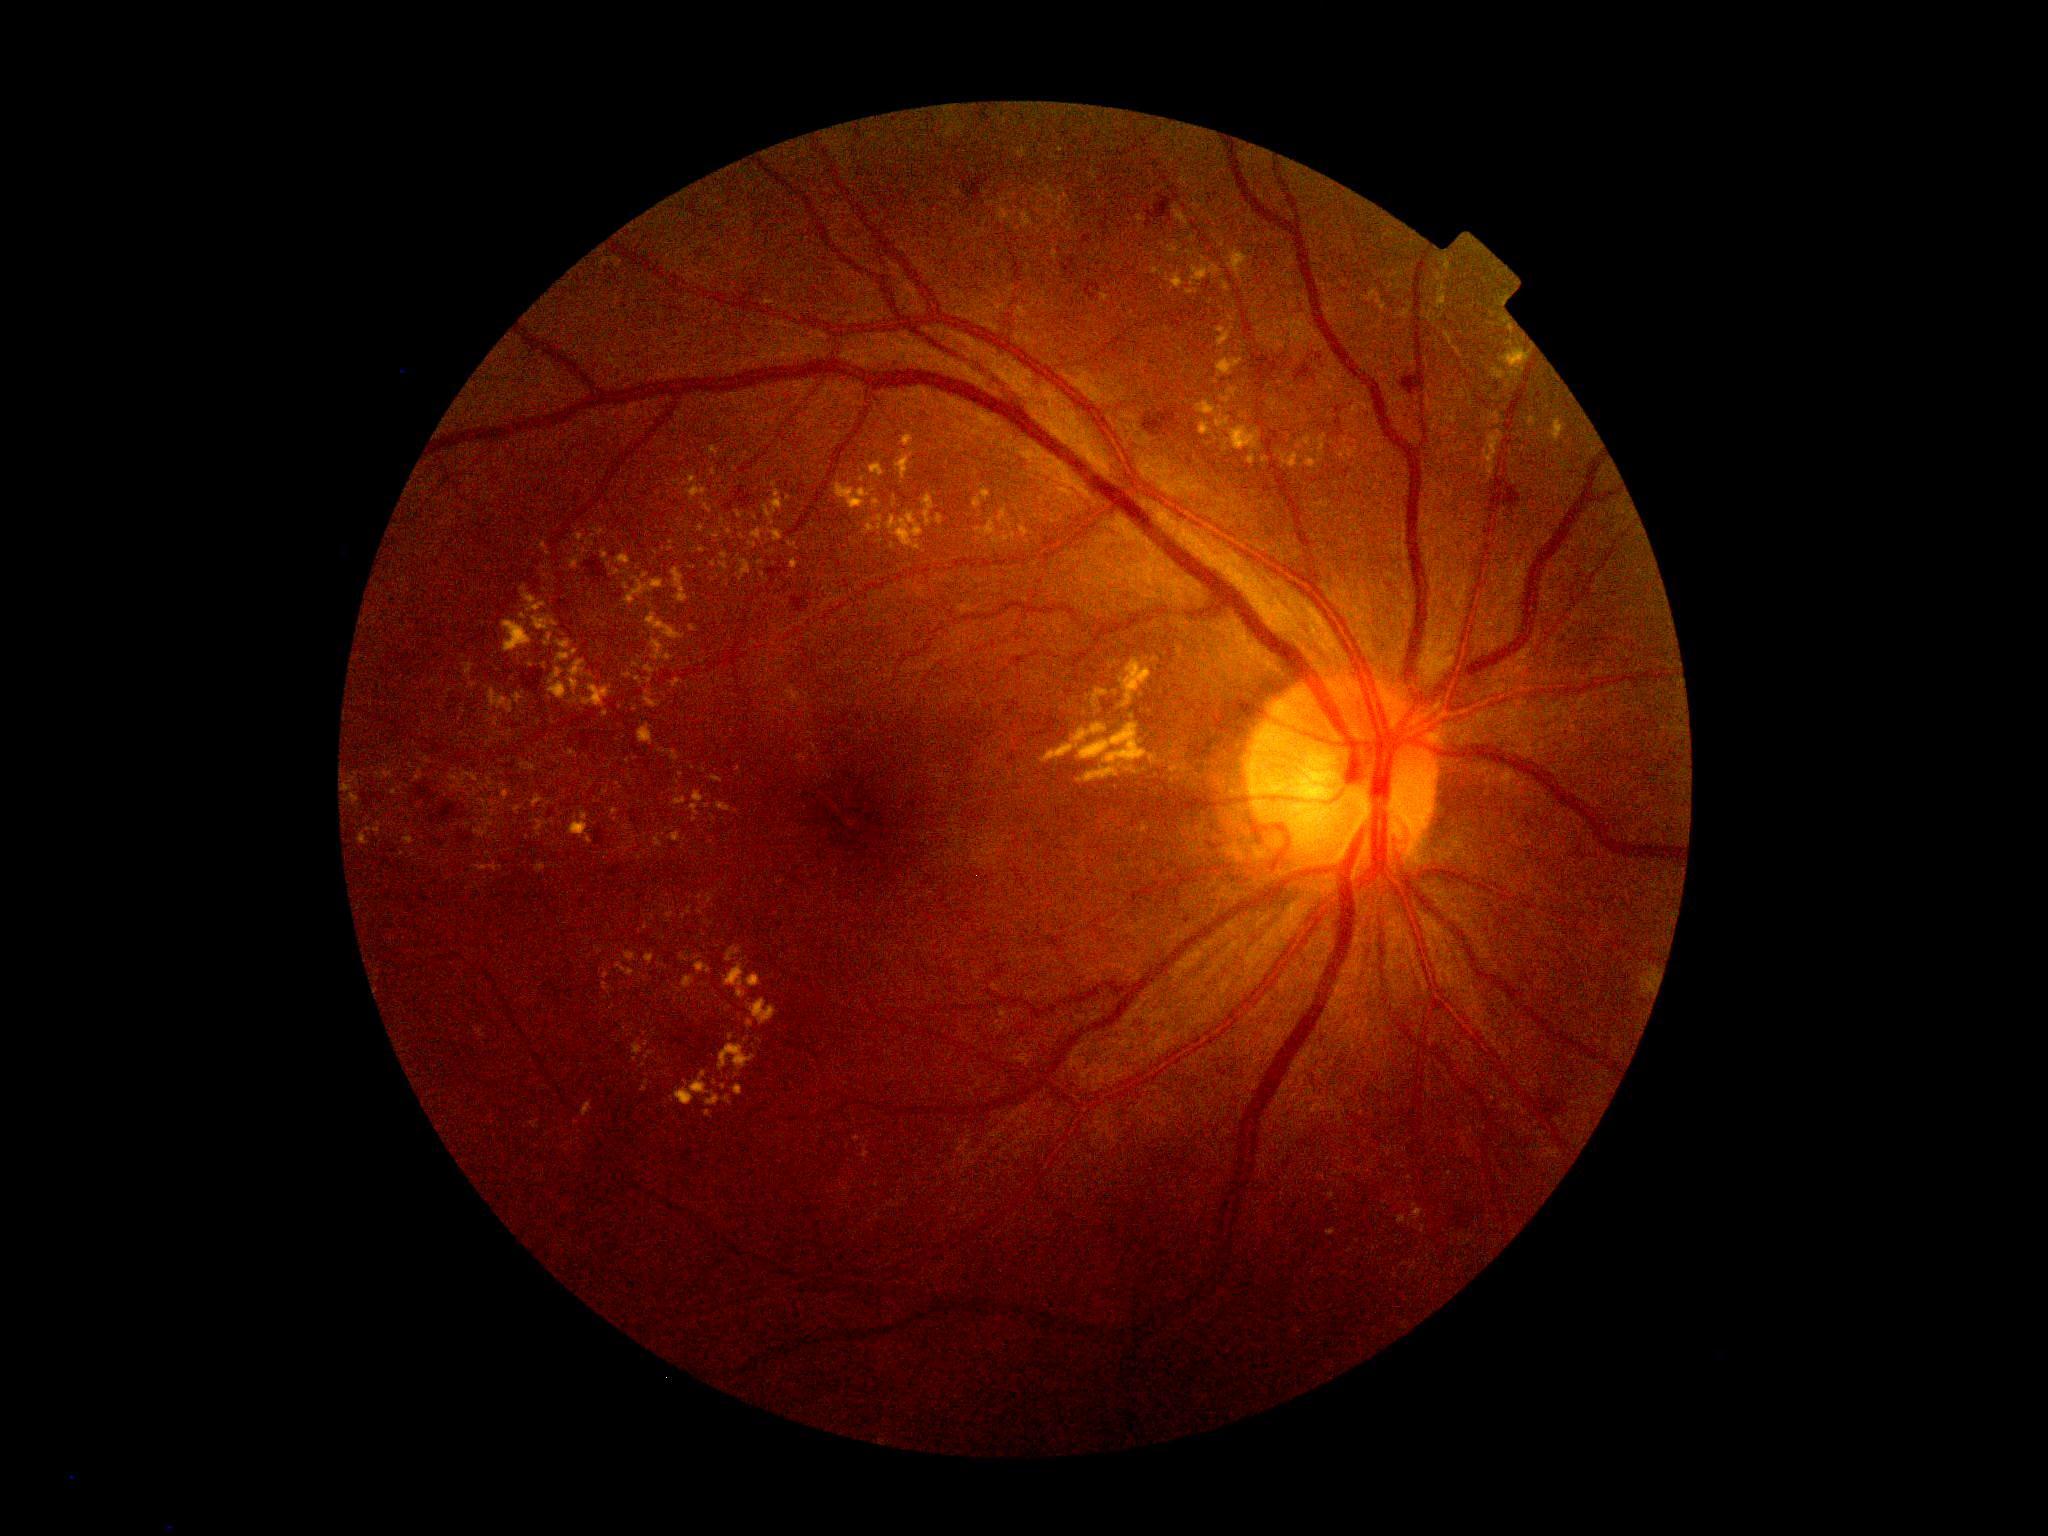
DR severity: 2/4. The retinopathy is classified as non-proliferative diabetic retinopathy.